1240x1240. Wide-field fundus photograph of an infant:
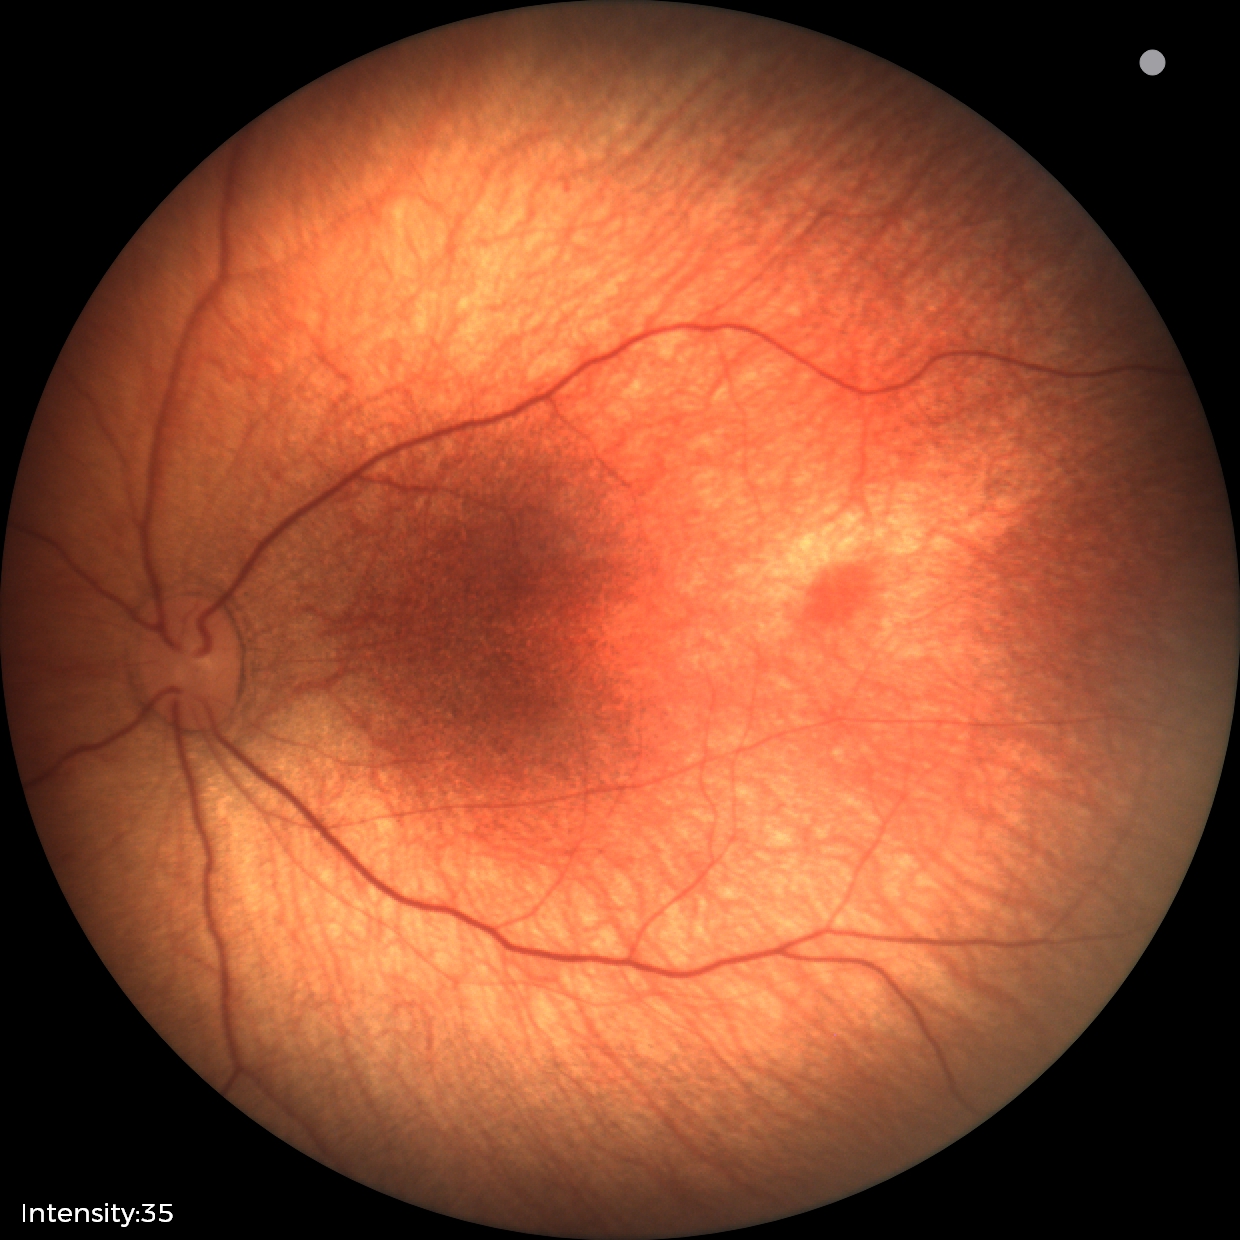

Screening diagnosis: normal retinal appearance.